Pediatric retinal photograph (wide-field) · Phoenix ICON, 100° FOV.
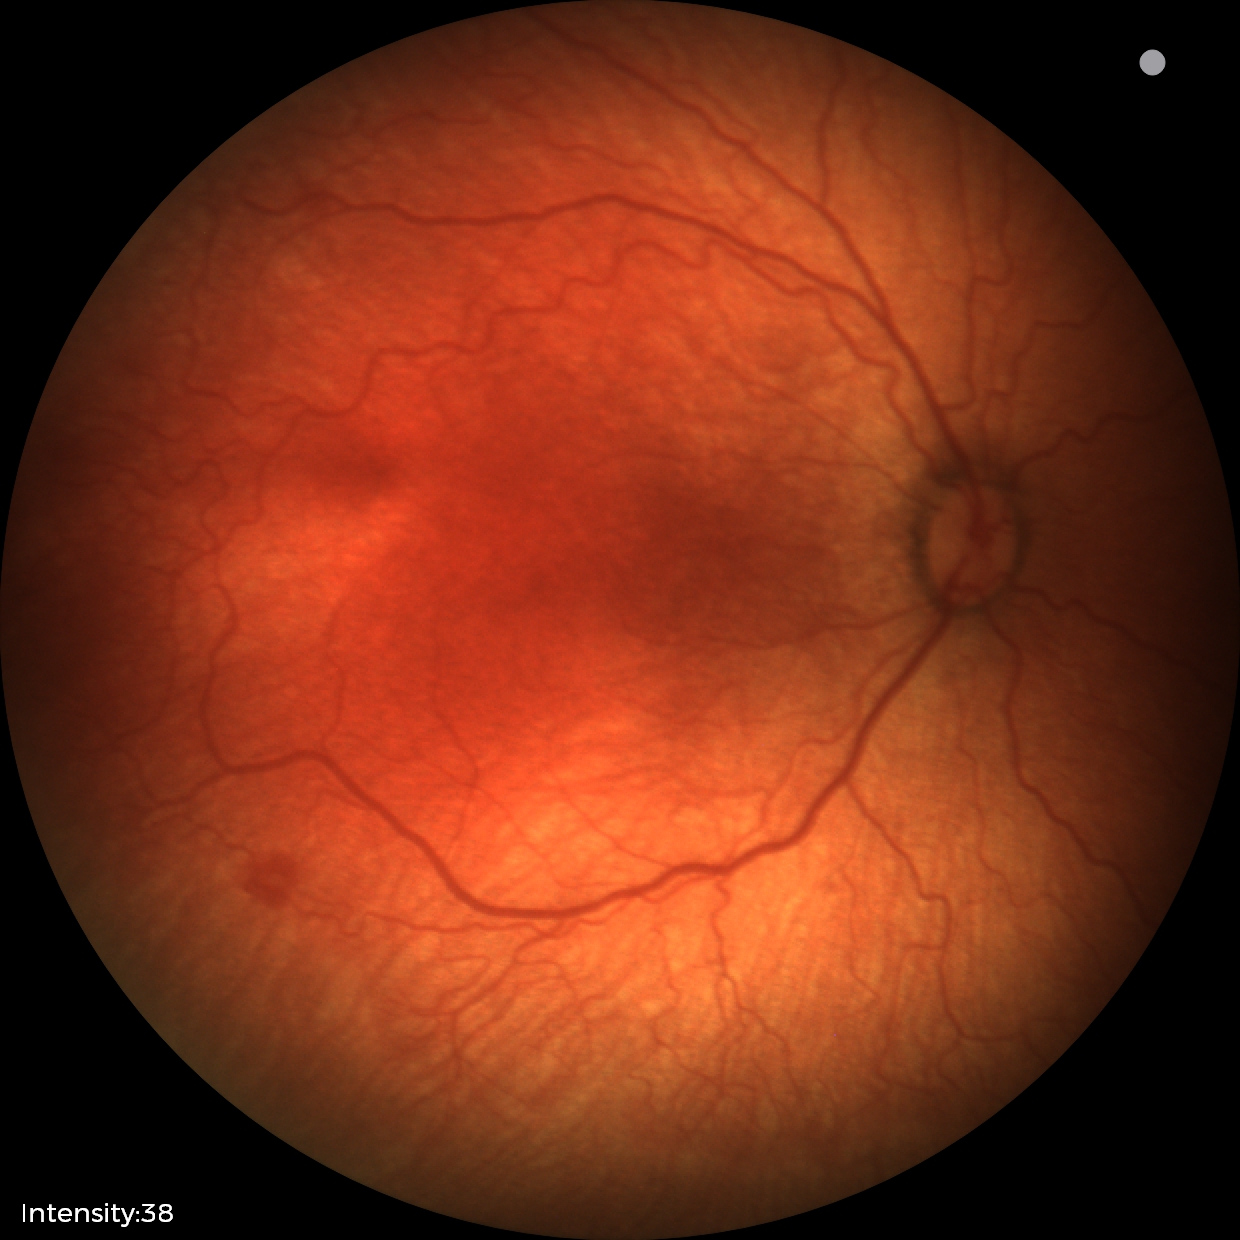

Plus disease: absent, retinopathy of prematurity (ROP) stage: 1.